Clarity RetCam 3, 130° FOV; wide-field fundus photograph of an infant; 640 x 480 pixels:
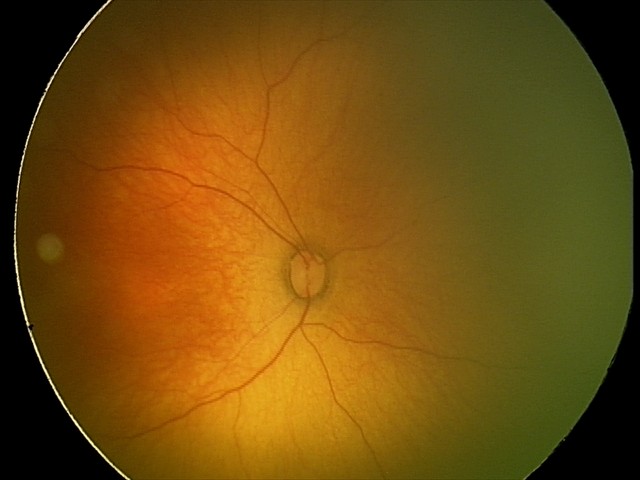 Diagnosis from this screening exam: retinopathy of prematurity stage 1. Without plus disease.